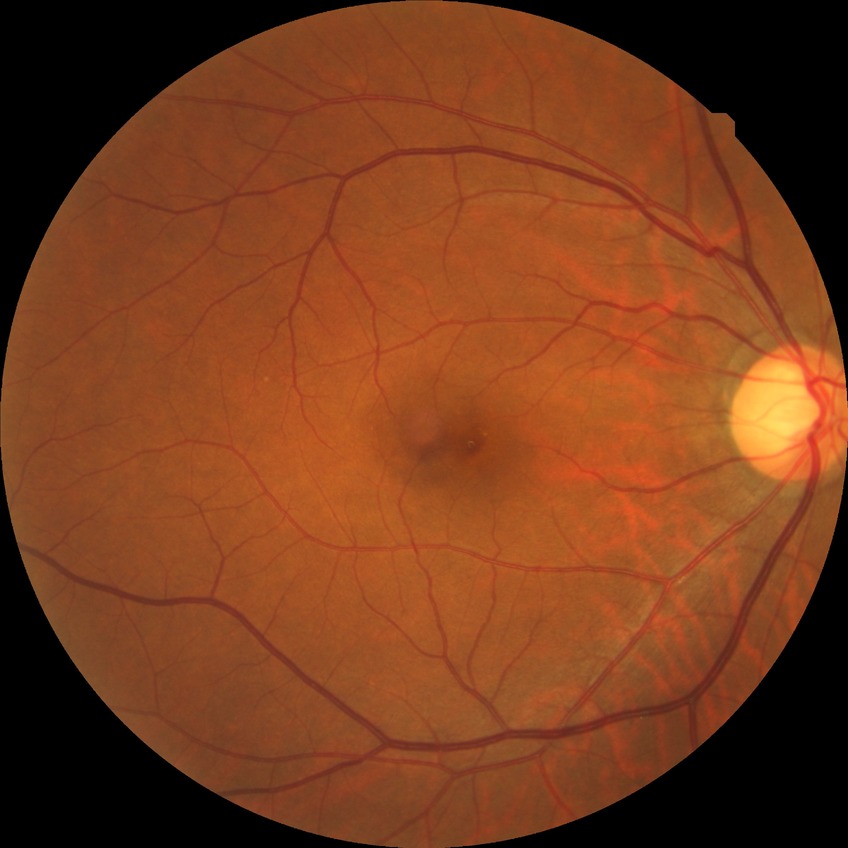

retinopathy stage: no diabetic retinopathy.